No pharmacologic dilation.
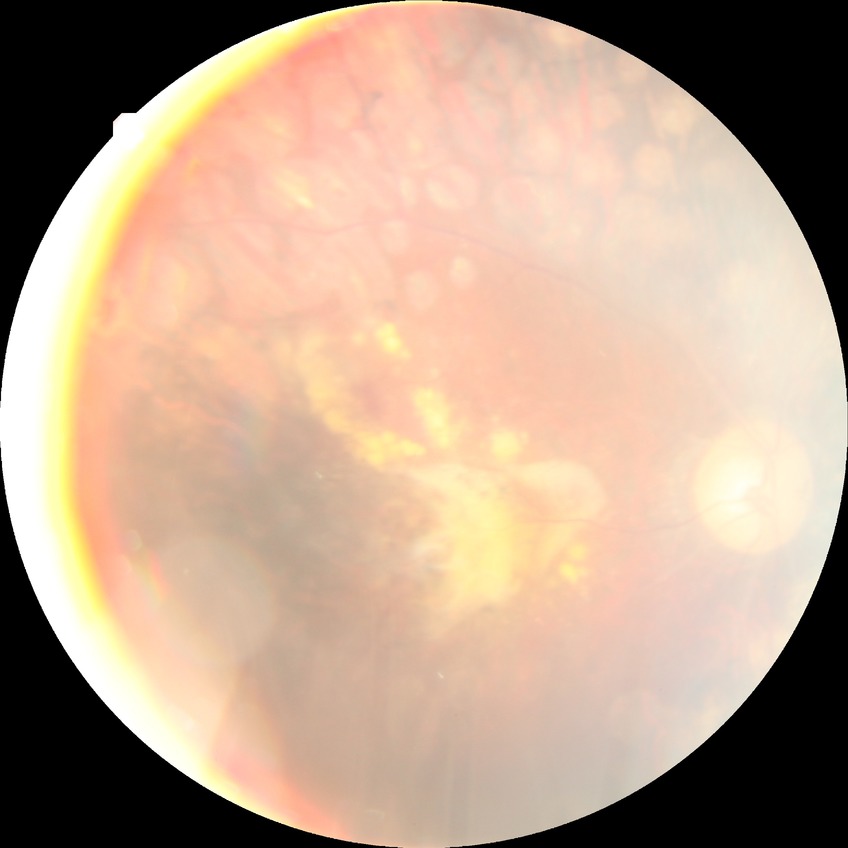
davis_grade: proliferative diabetic retinopathy (PDR)